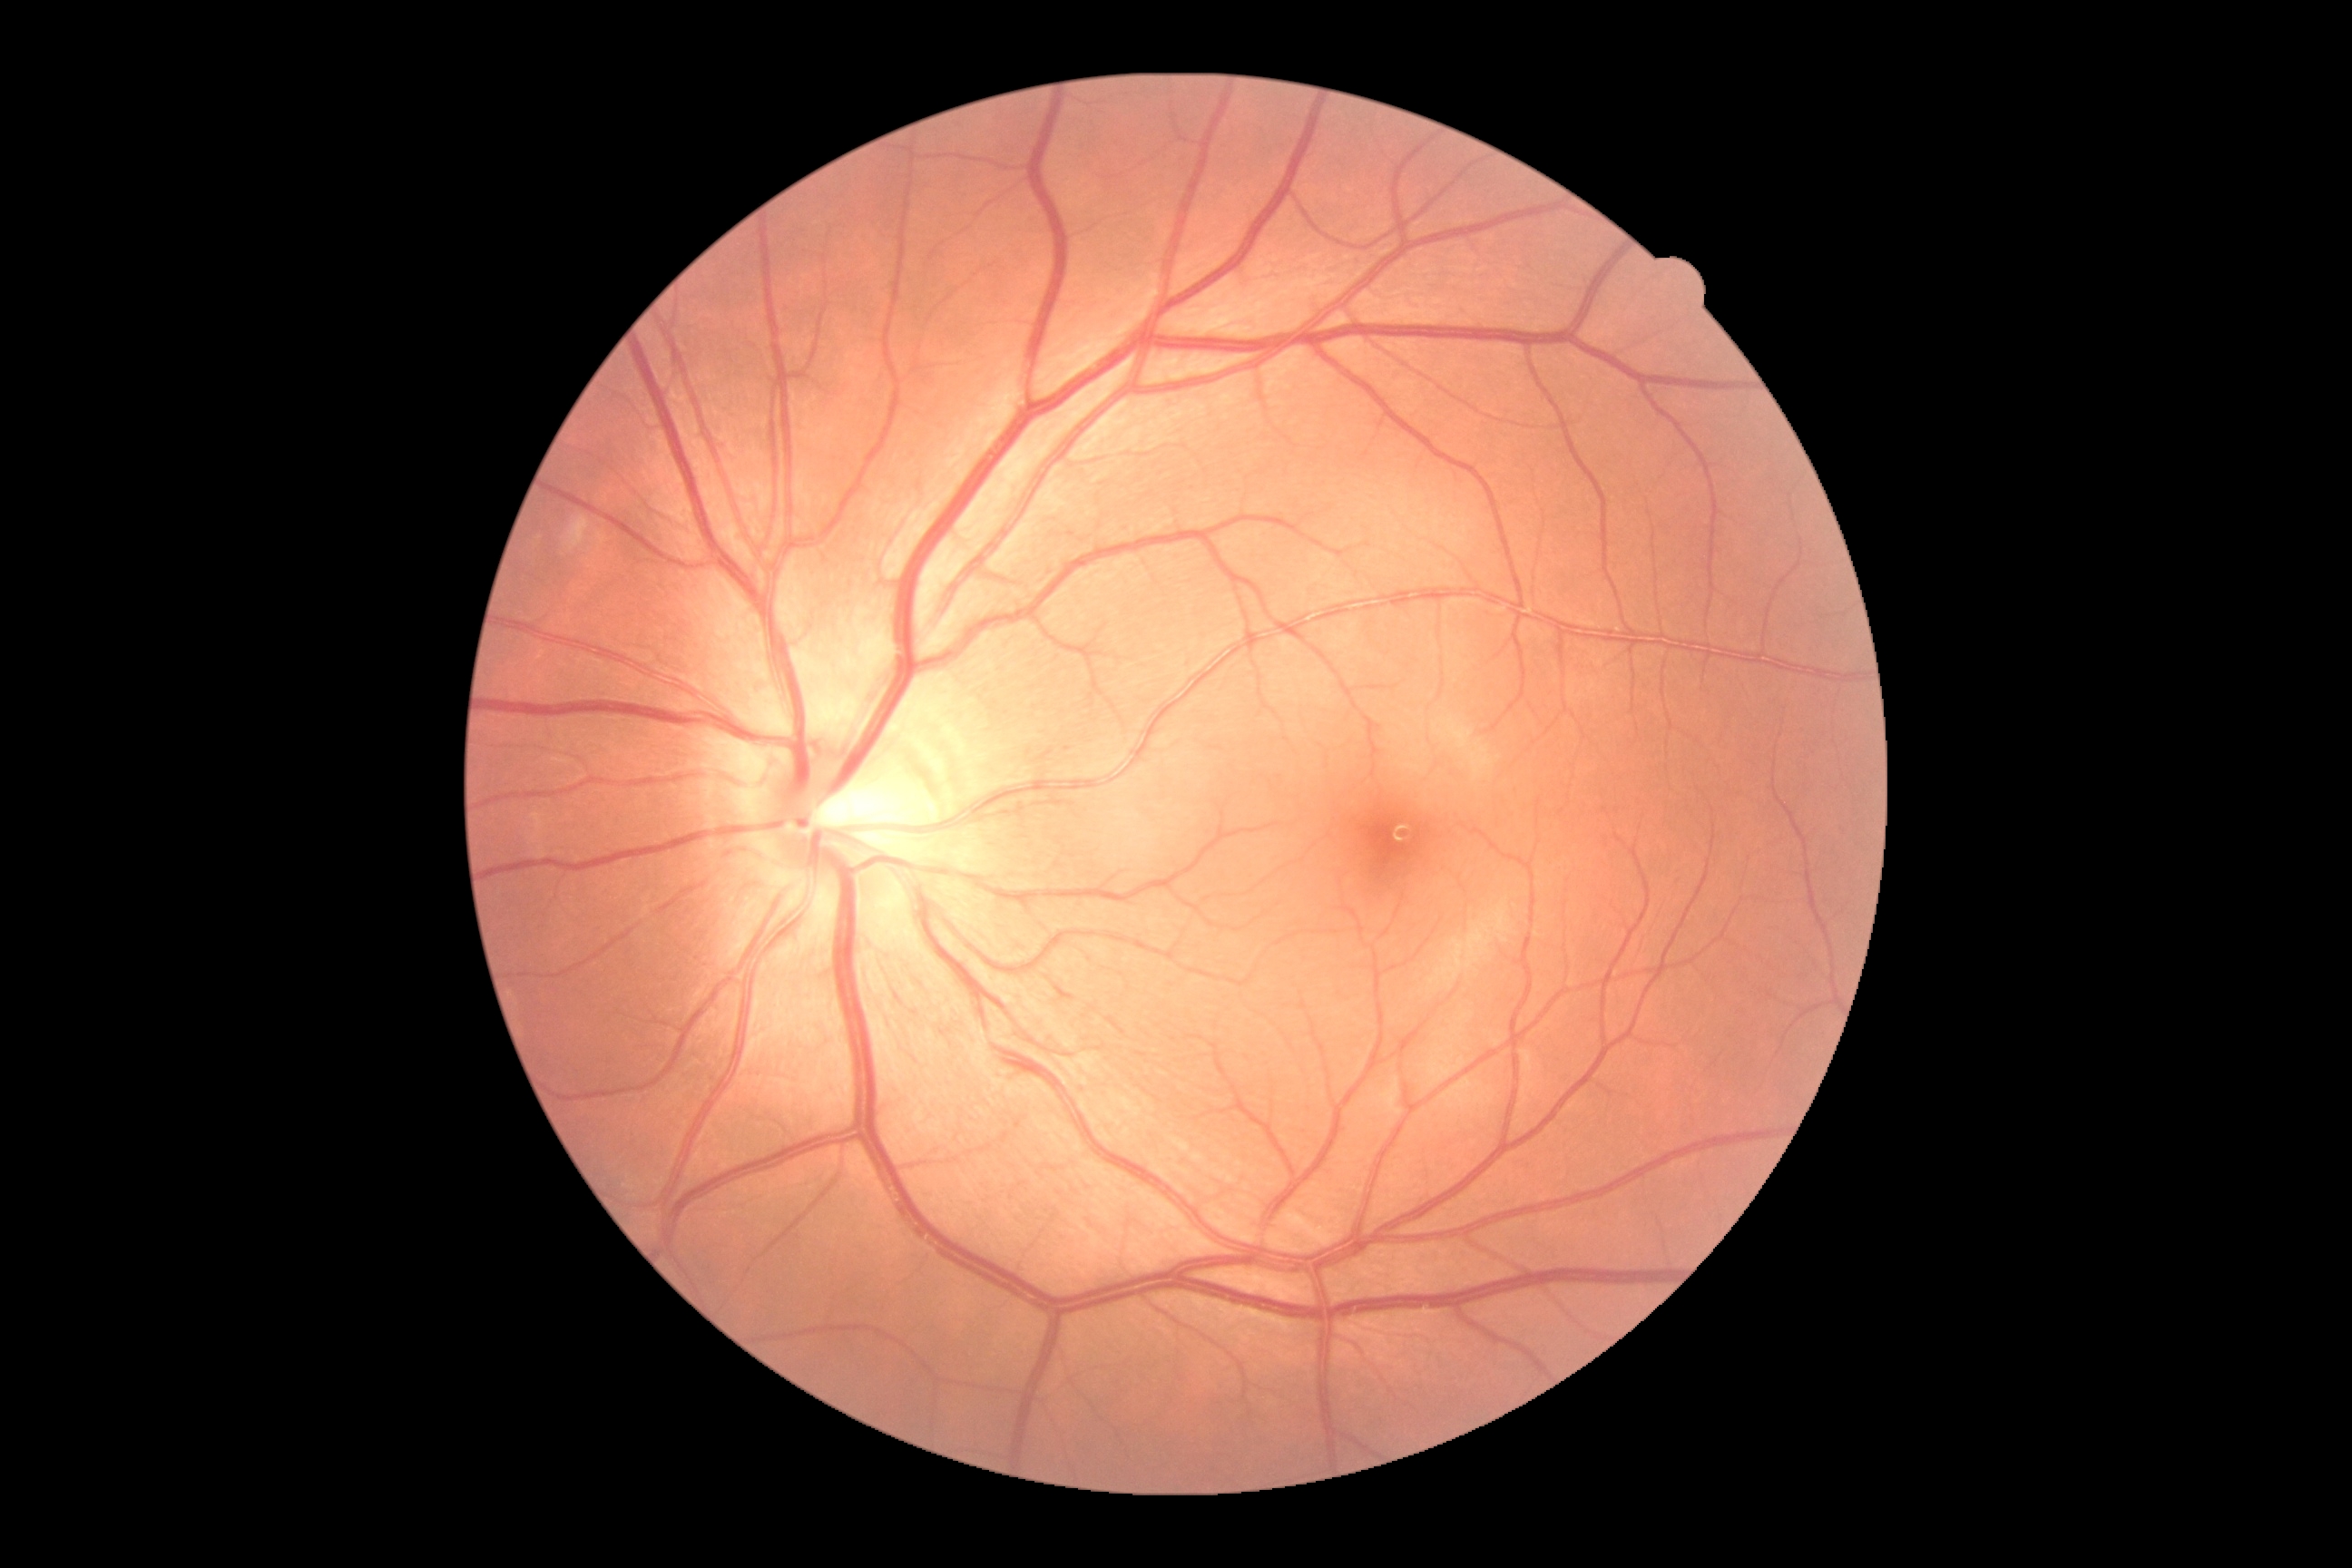
DR stage is grade 0.